Image size 1440x1080 · wide-field contact fundus photograph of an infant:
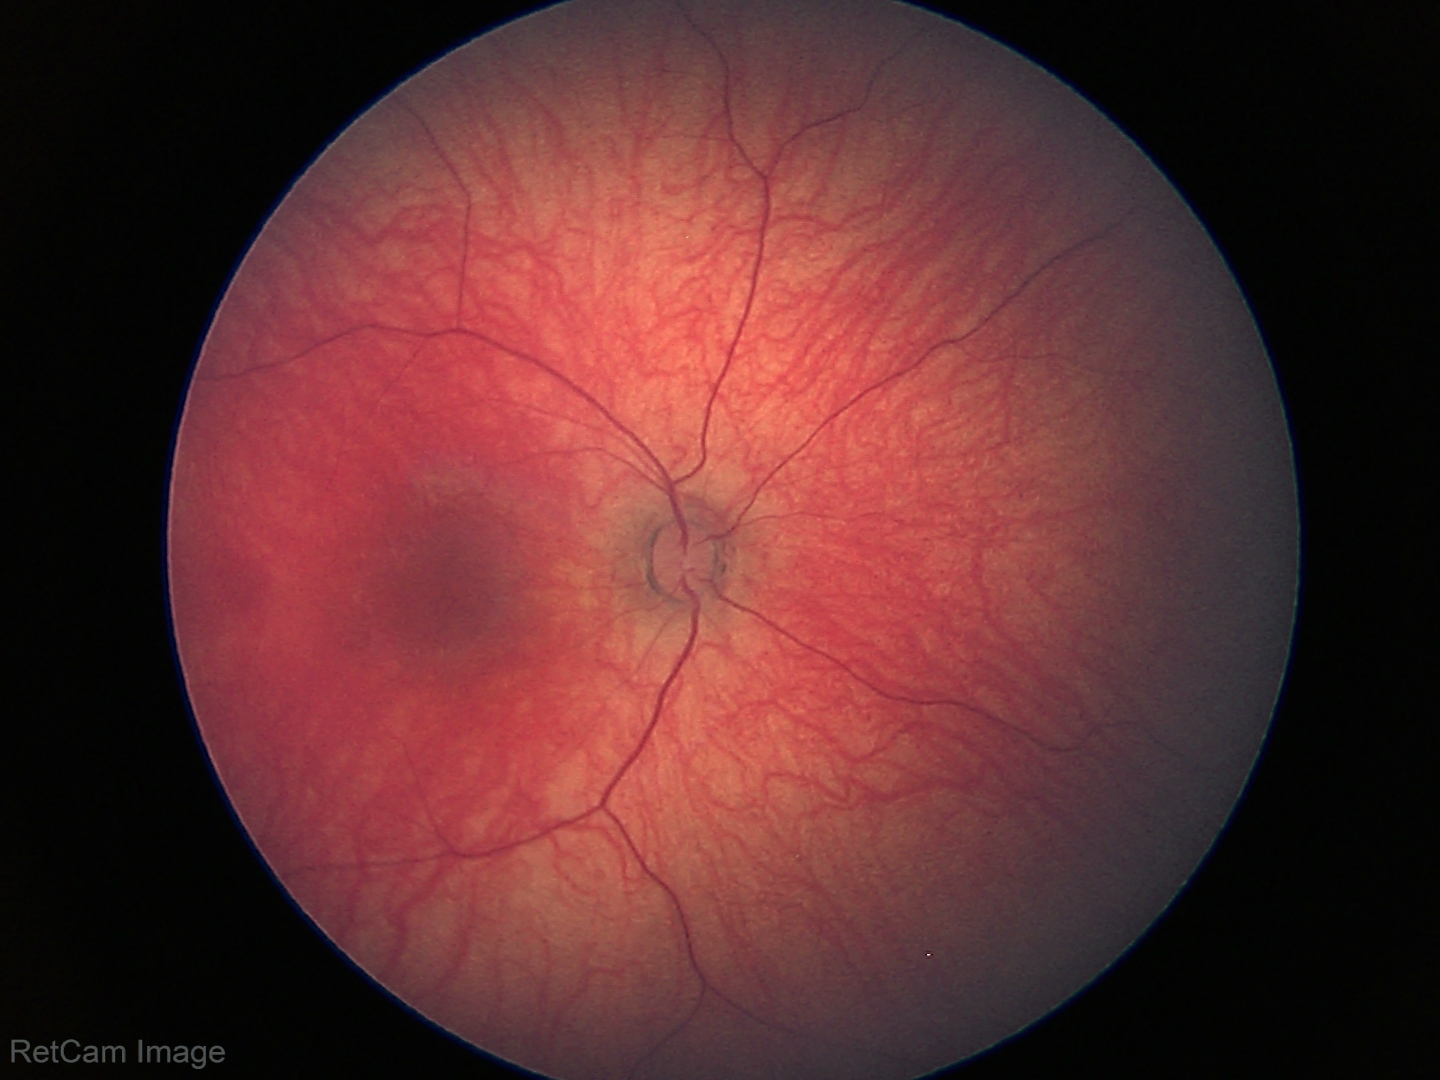
Screening examination diagnosed as physiological.